FOV: 50 degrees; 1924x1556; fundus photo — 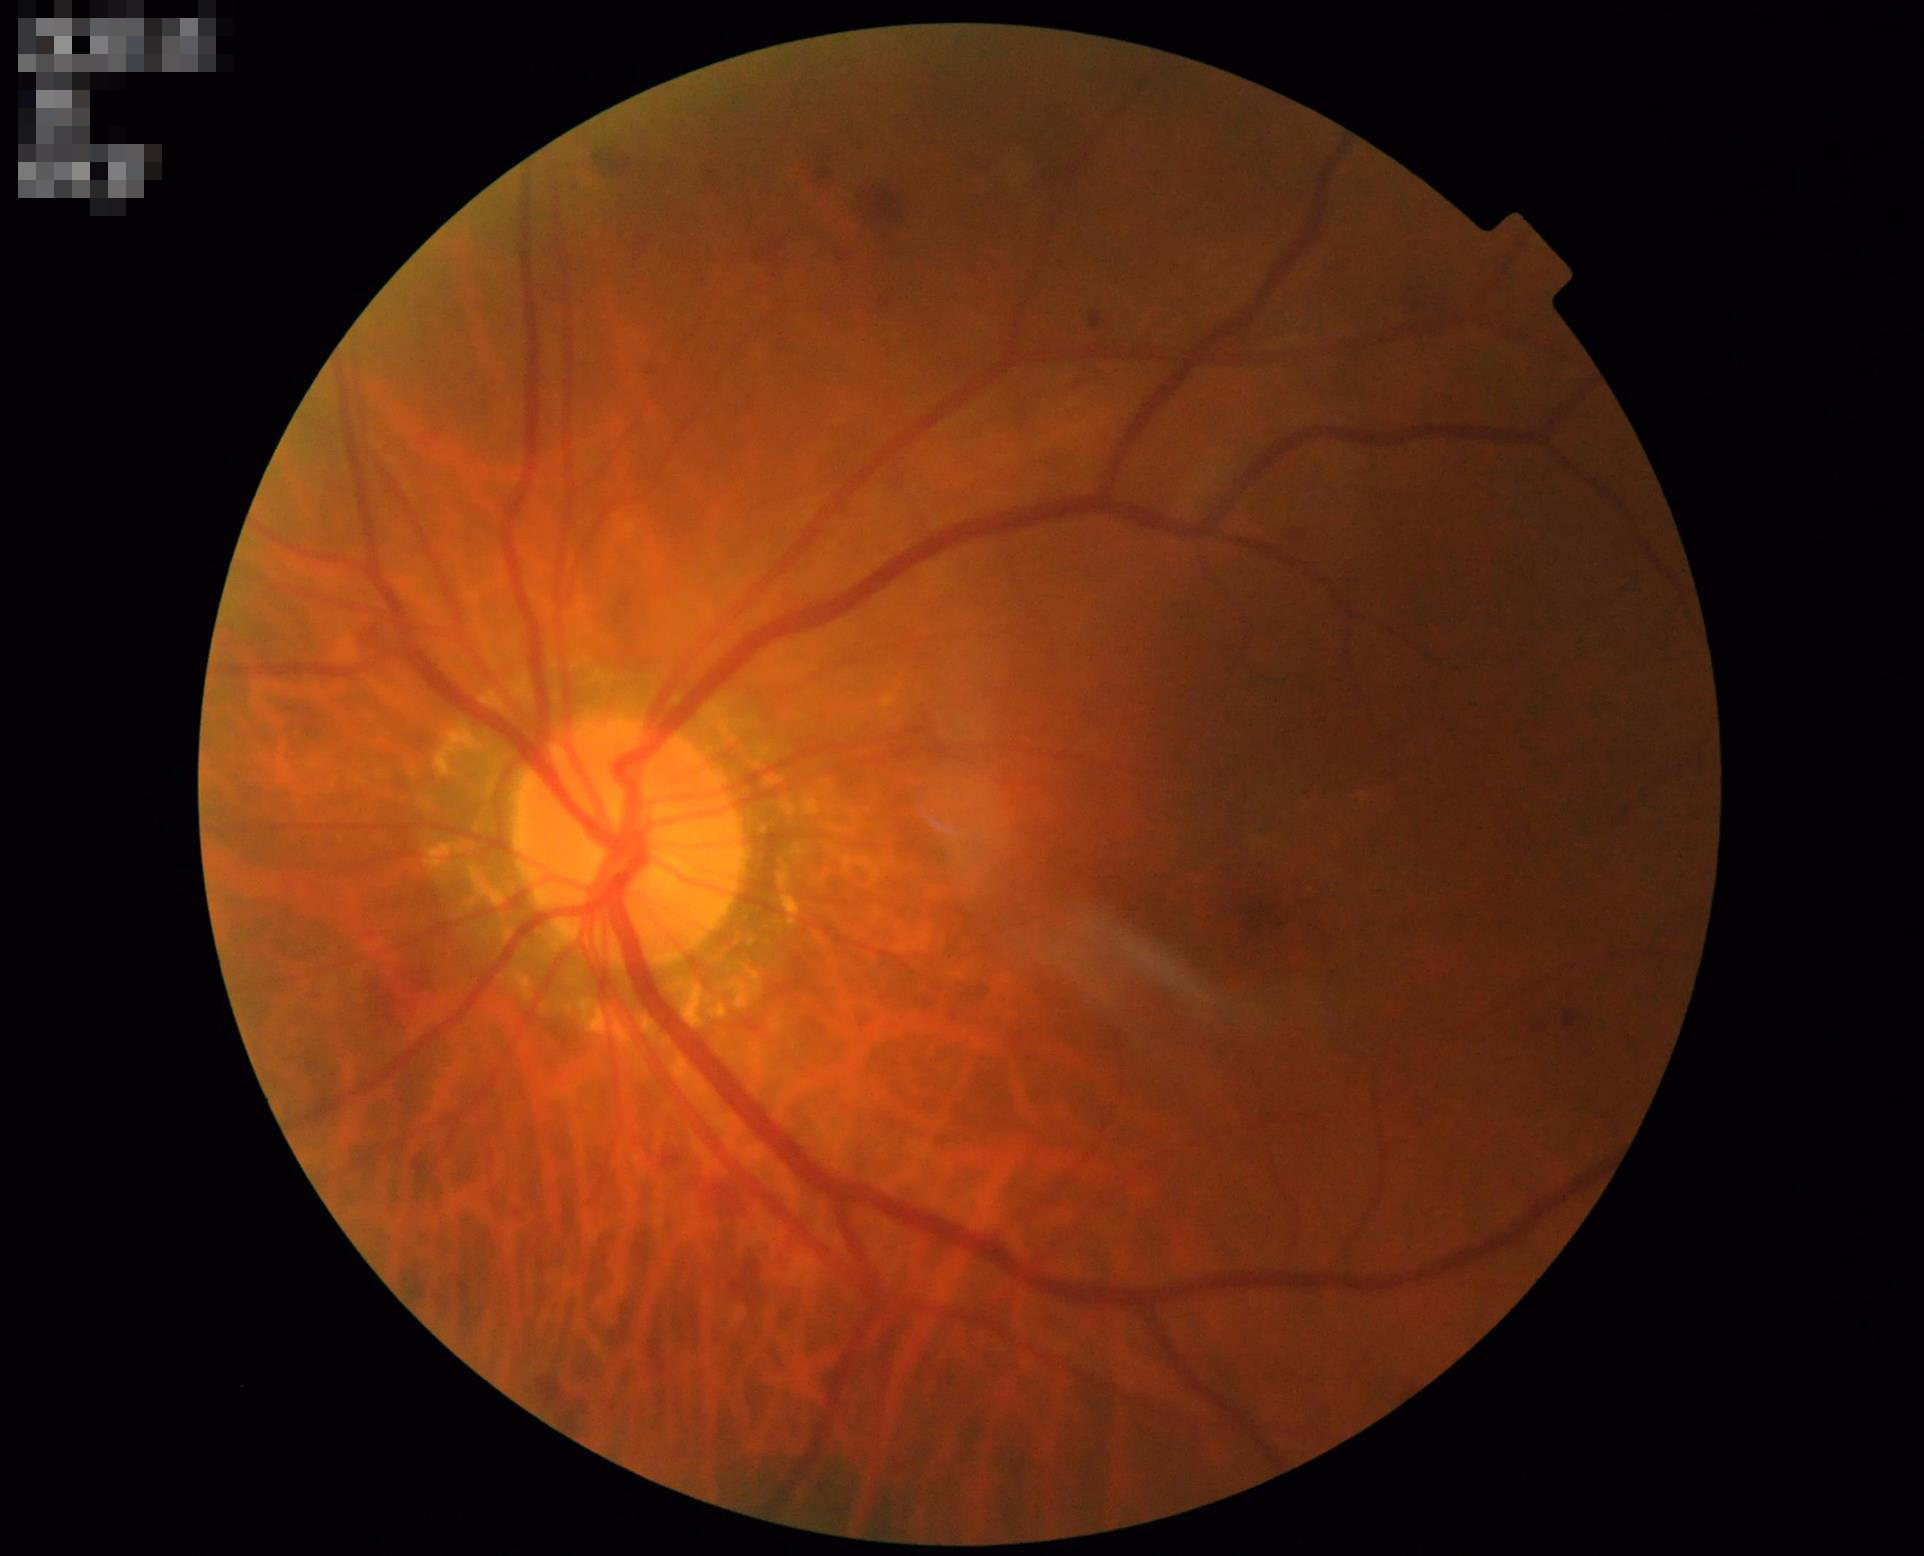

Overall quality is good and the image is gradable. Contrast is good. Even illumination with no color cast. The image is clear.